Captured with the Clarity RetCam 3 (130° field of view); pediatric retinal photograph (wide-field) — 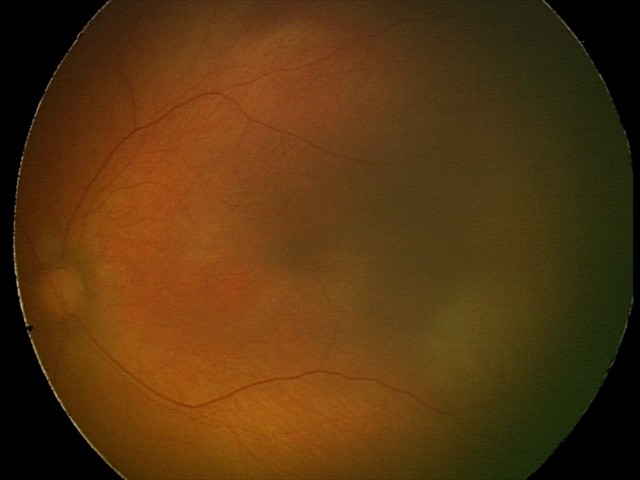

Finding = normal retinal appearance